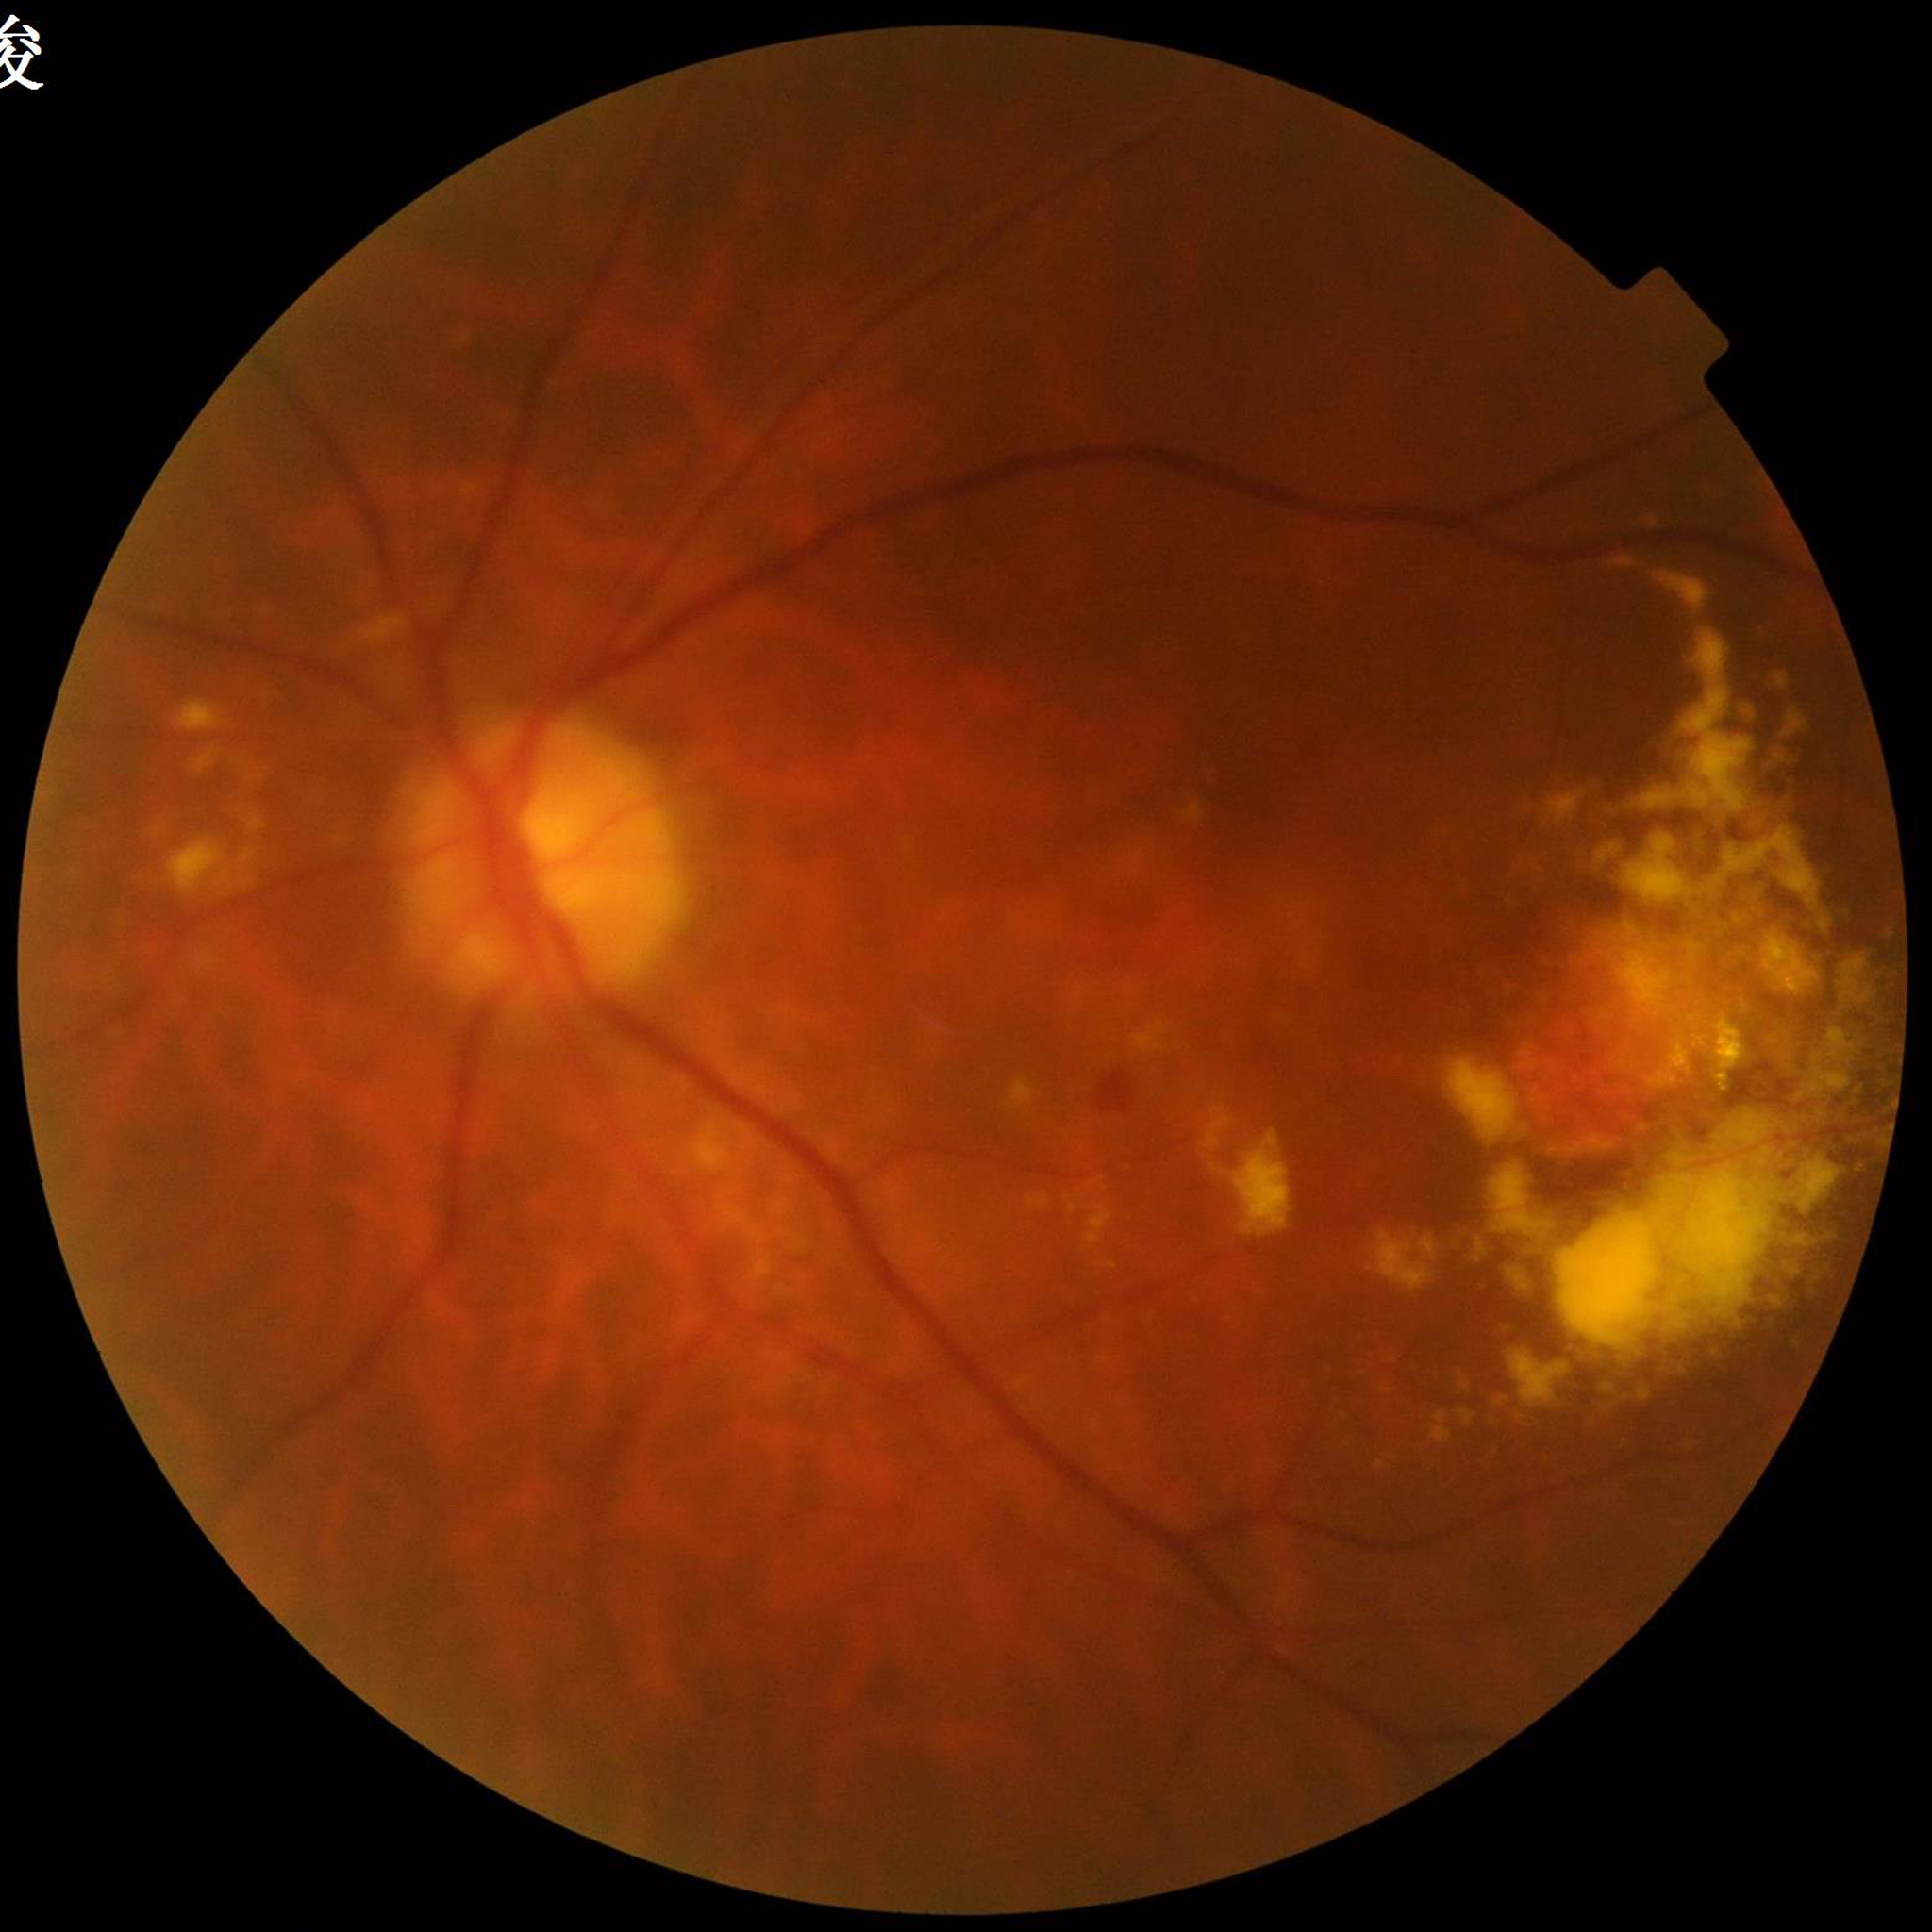 image_quality: illumination and color satisfactory, contrast adequate, blur present
diagnosis: age-related macular degeneration